Acquired on the Phoenix ICON. Wide-field contact fundus photograph of an infant — 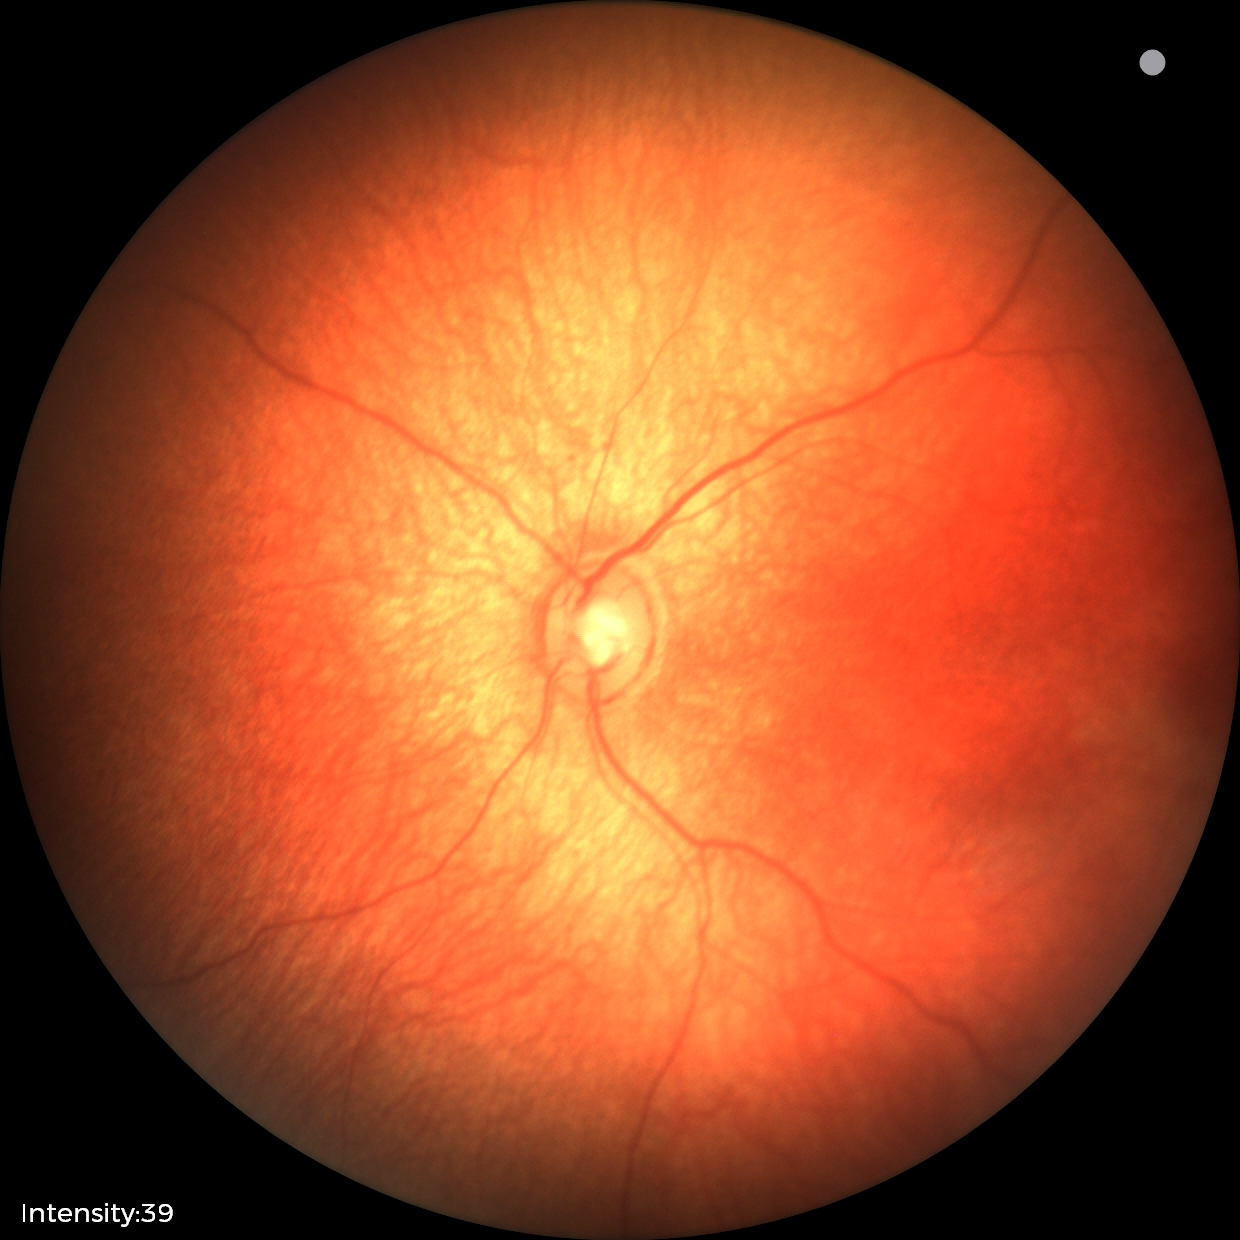
Screening examination diagnosed as physiological.